Diabetic retinopathy graded by the modified Davis classification:
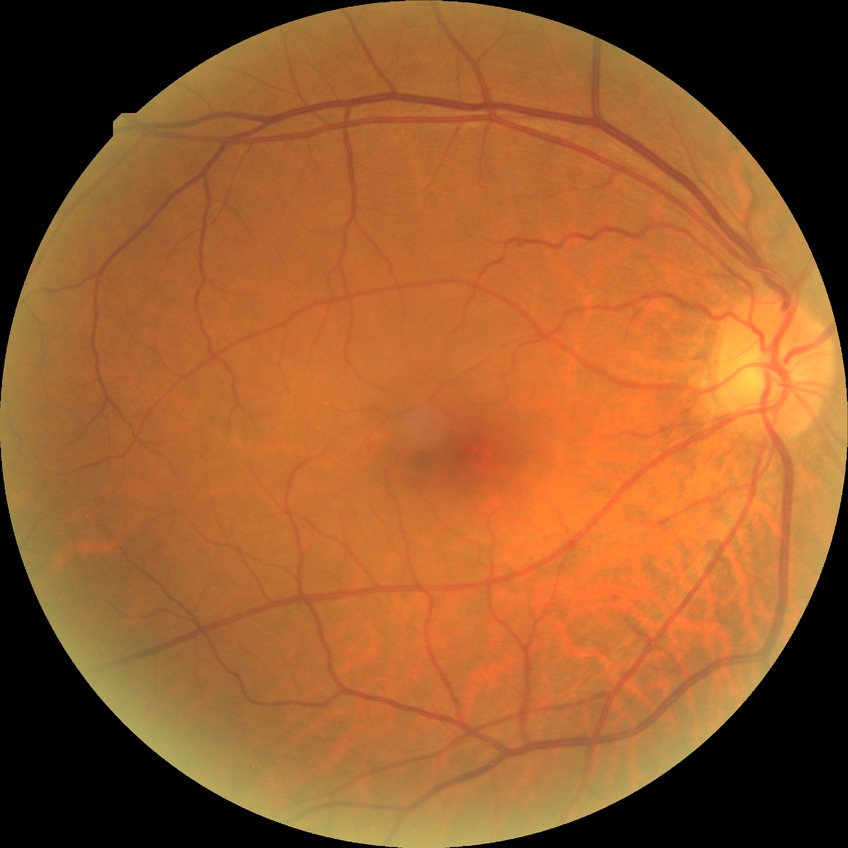

Diabetic retinopathy severity: no diabetic retinopathy.